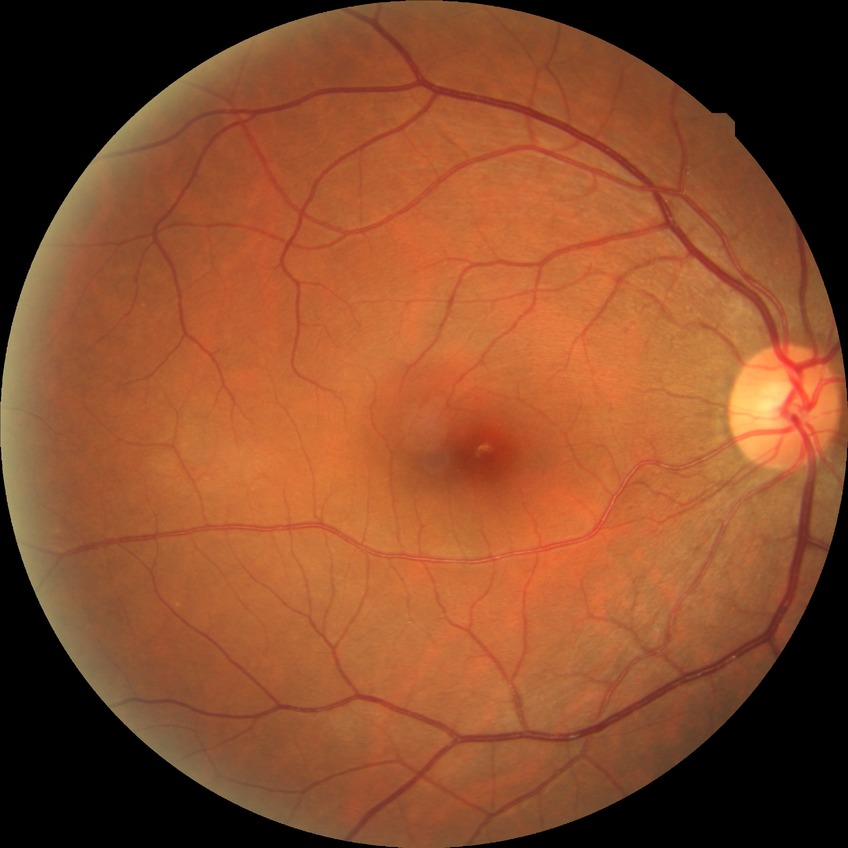

Findings:
* diabetic retinopathy (DR) — NDR (no diabetic retinopathy)